FOV: 45 degrees, image size 2352x1568.
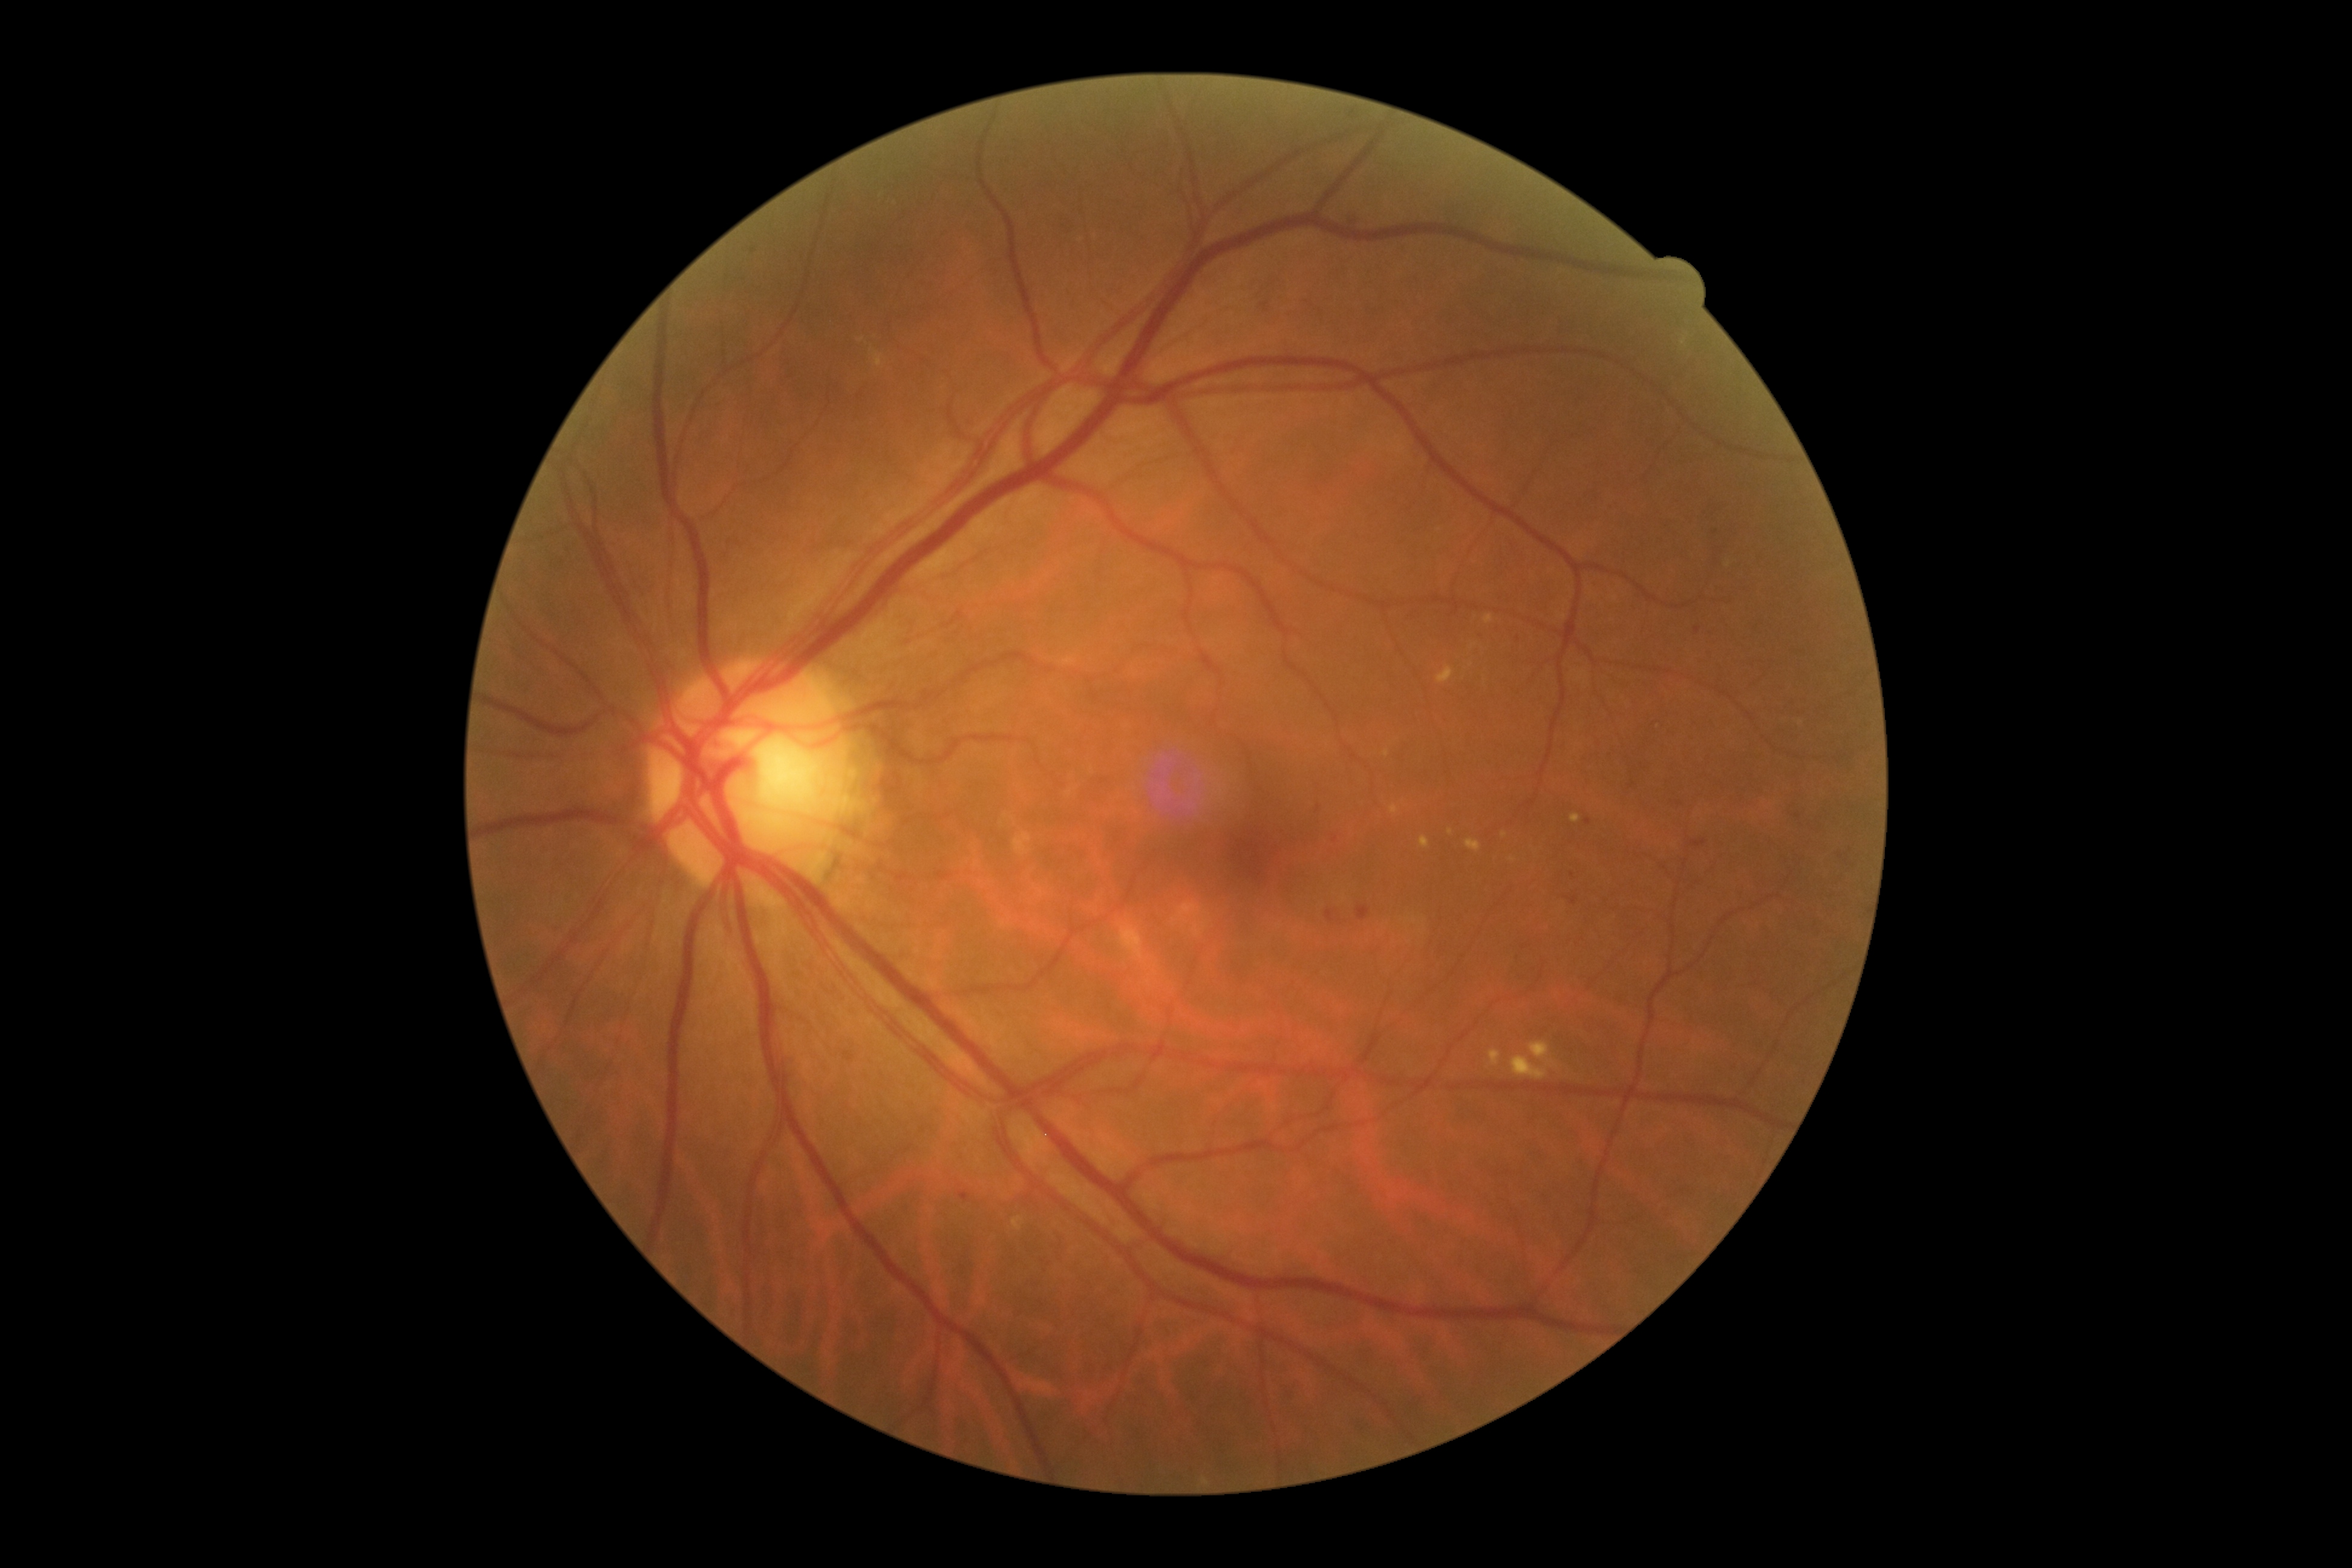
Disease class: non-proliferative diabetic retinopathy. Diabetic retinopathy is moderate non-proliferative diabetic retinopathy (grade 2).